848x848px:
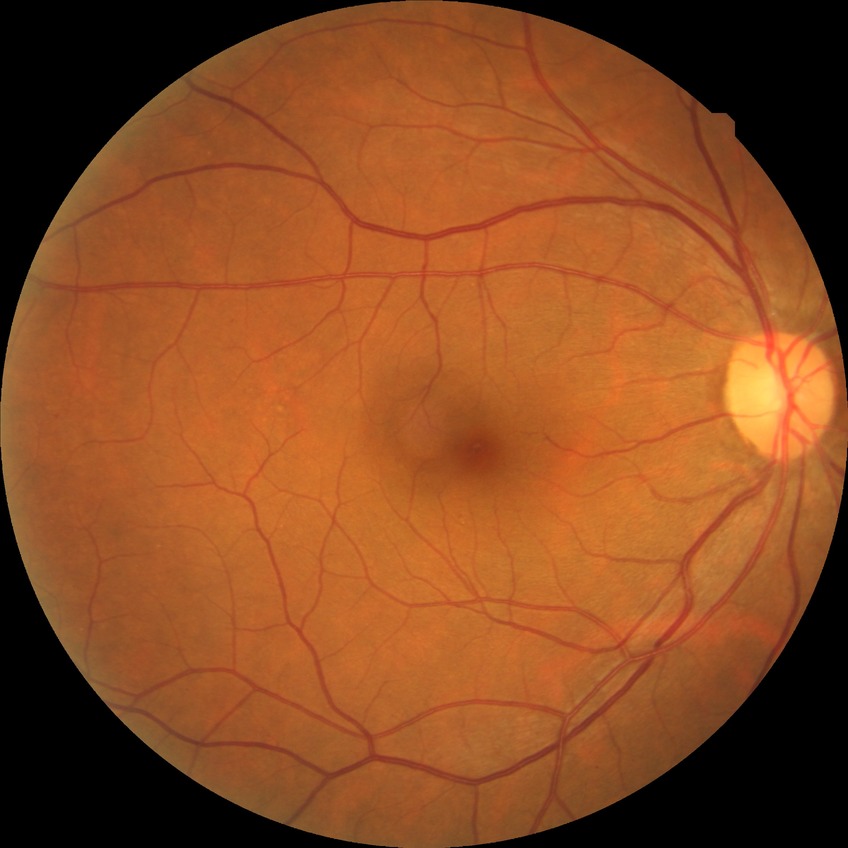

diabetic retinopathy (DR): simple diabetic retinopathy (SDR).